Wide-field fundus photograph from neonatal ROP screening; Clarity RetCam 3, 130° FOV: 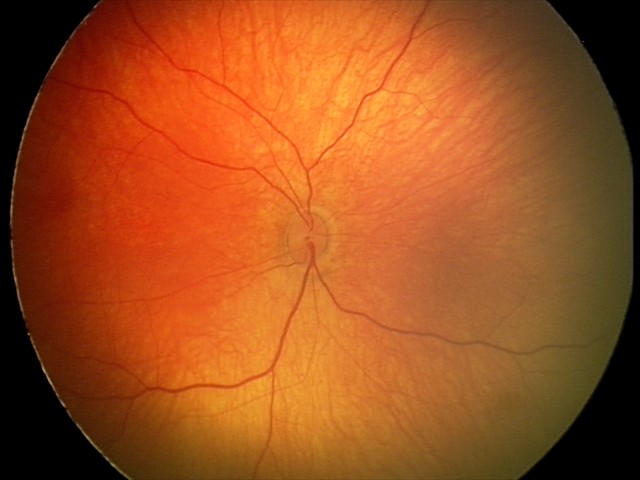 Diagnosis = retinal hemorrhages